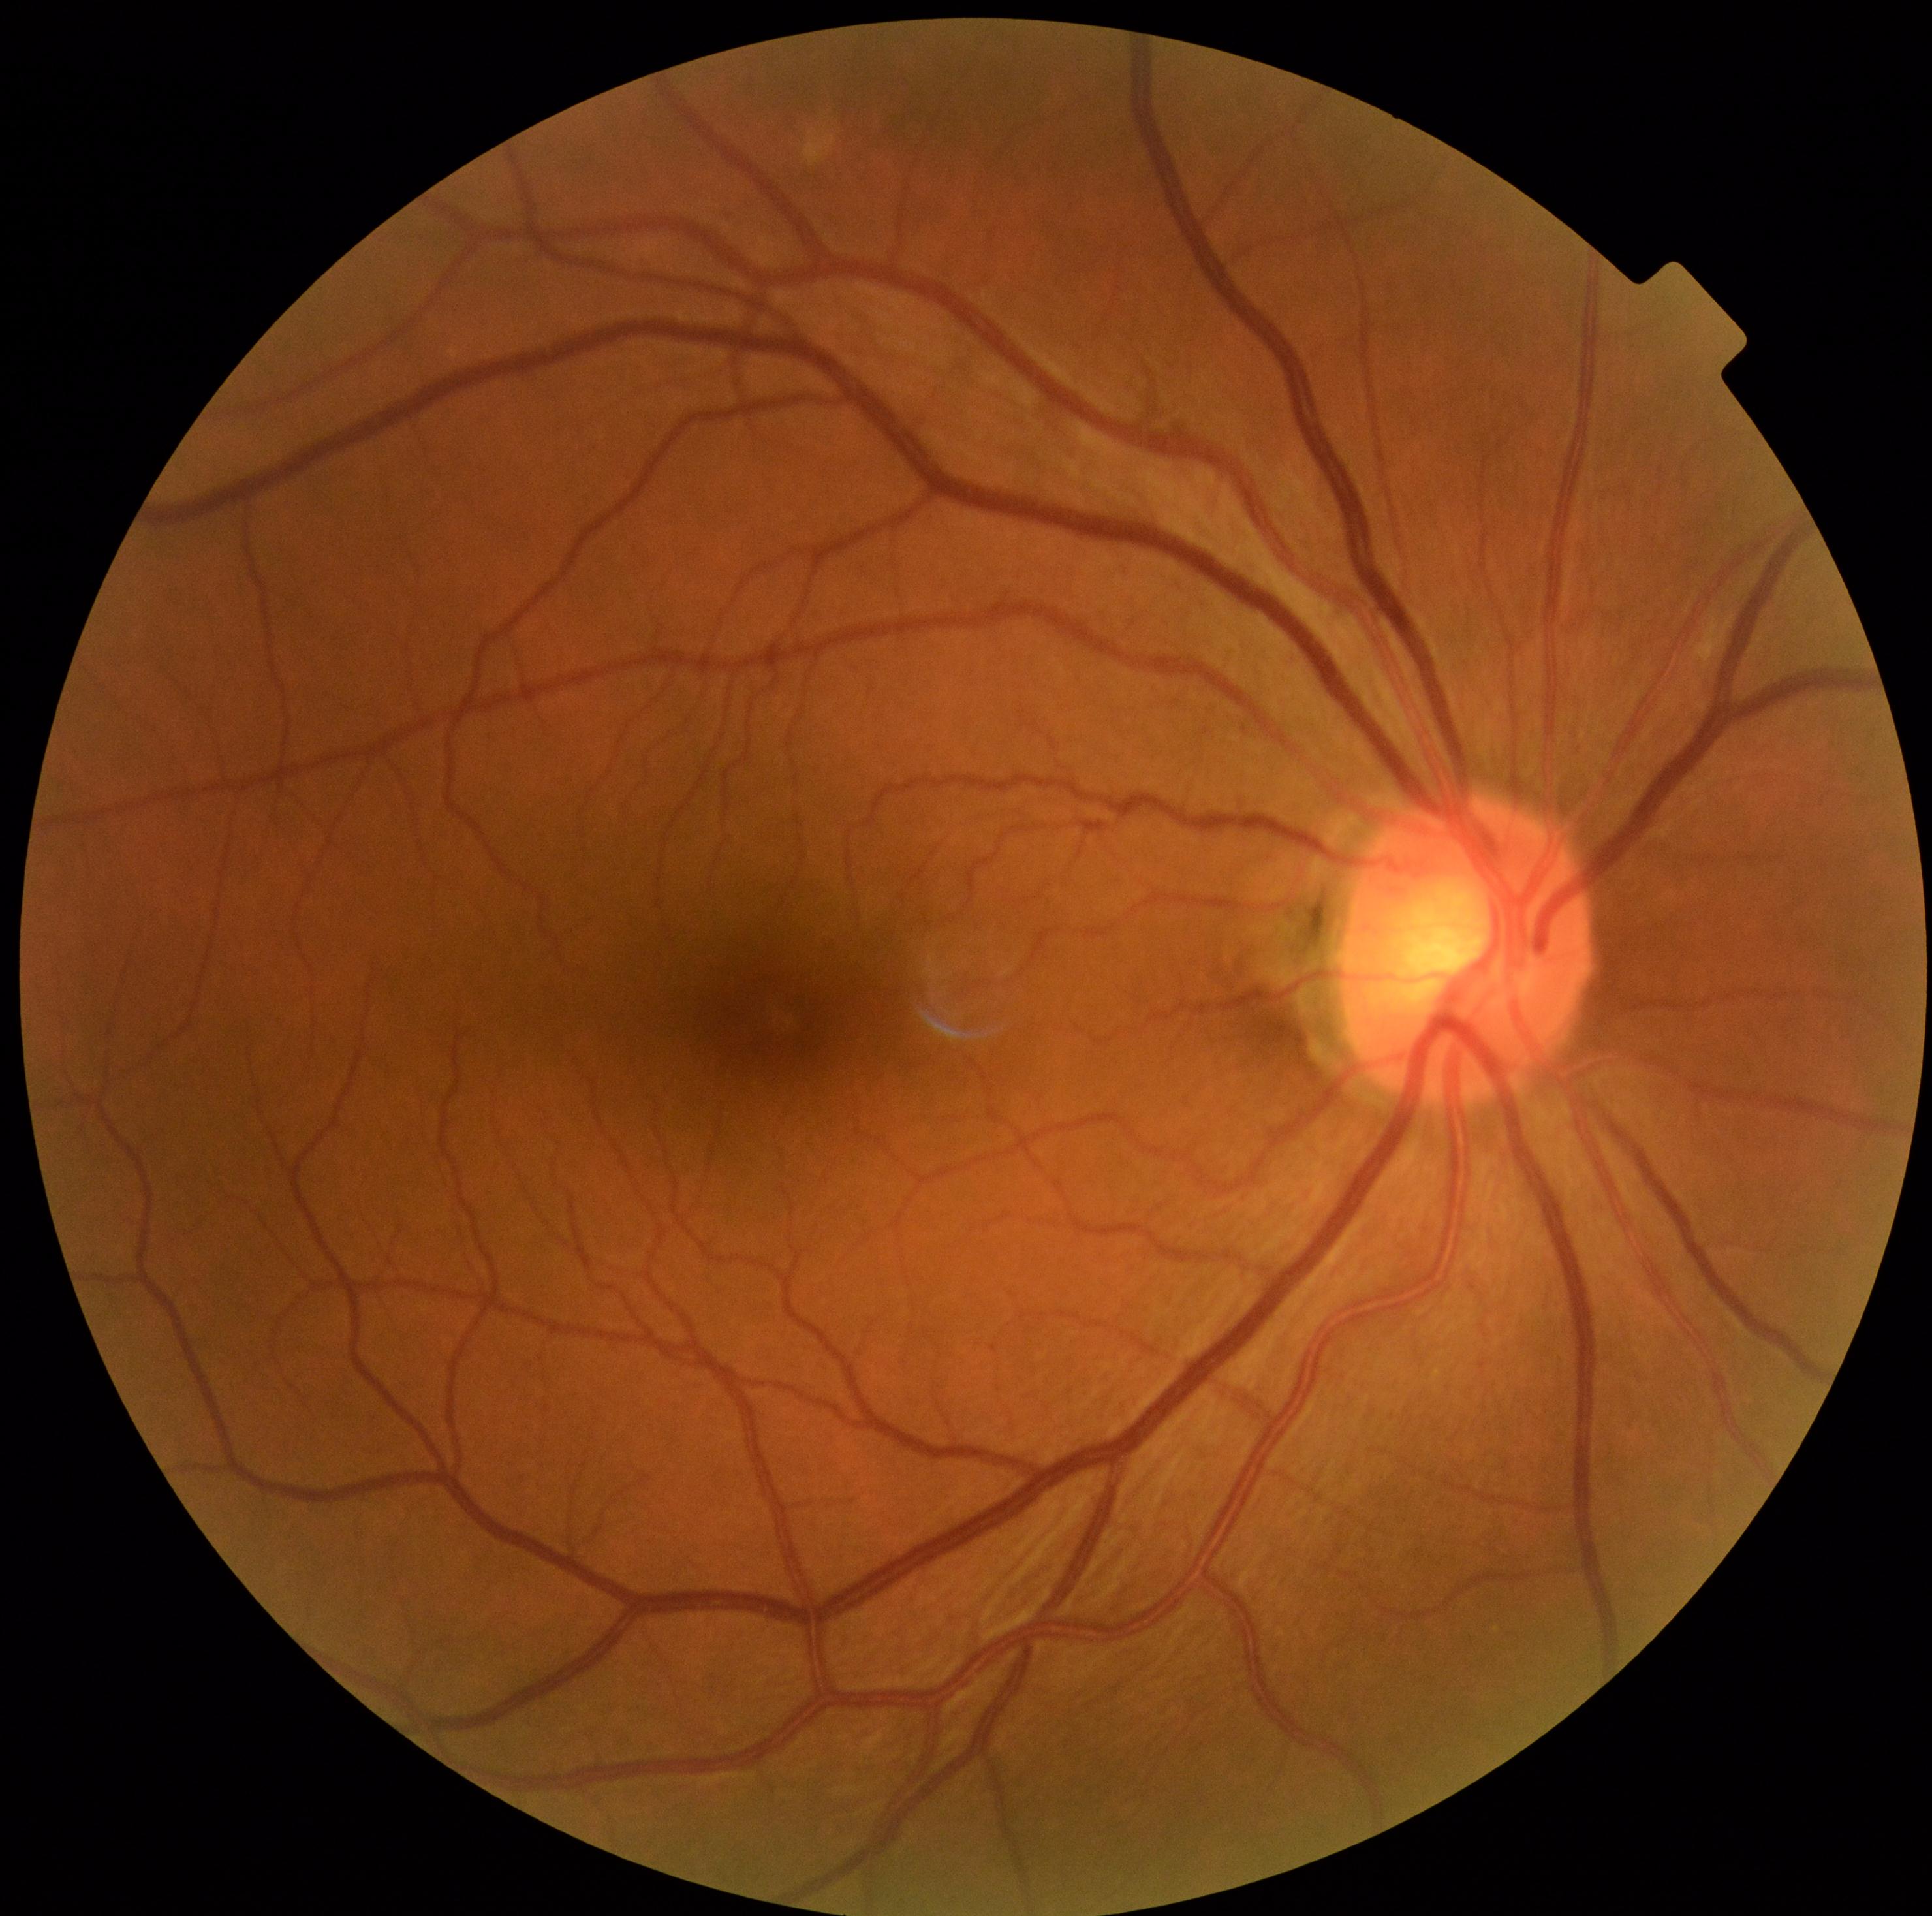

Diabetic retinopathy (DR) is grade 0 (no apparent retinopathy).